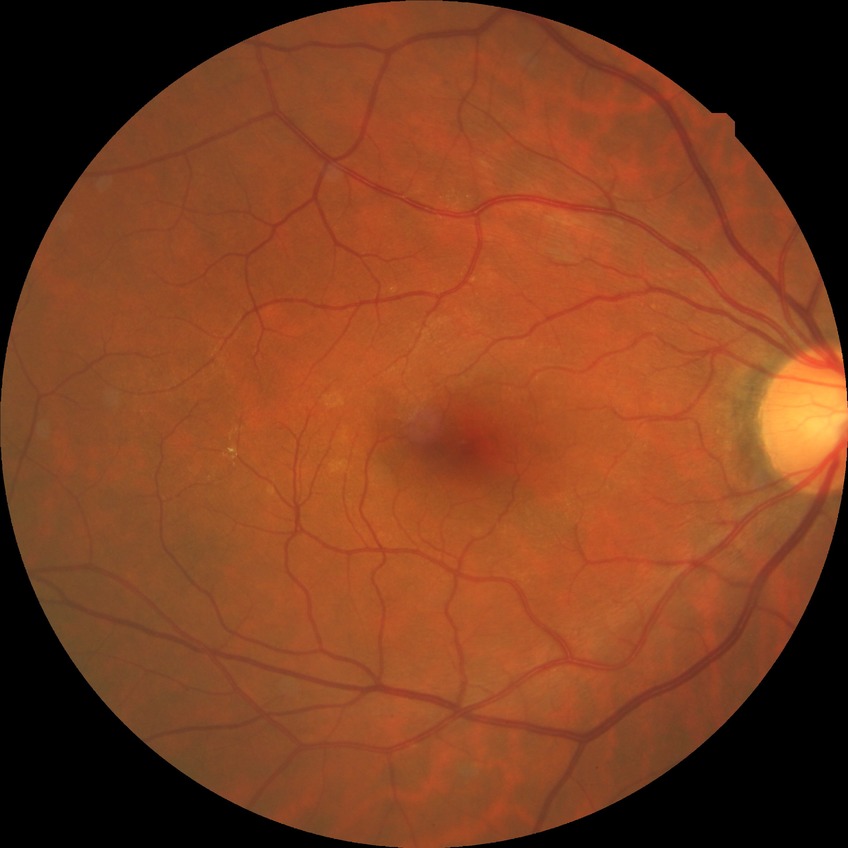 Davis grading is no diabetic retinopathy.